45° FOV; 2212 by 1659 pixels: 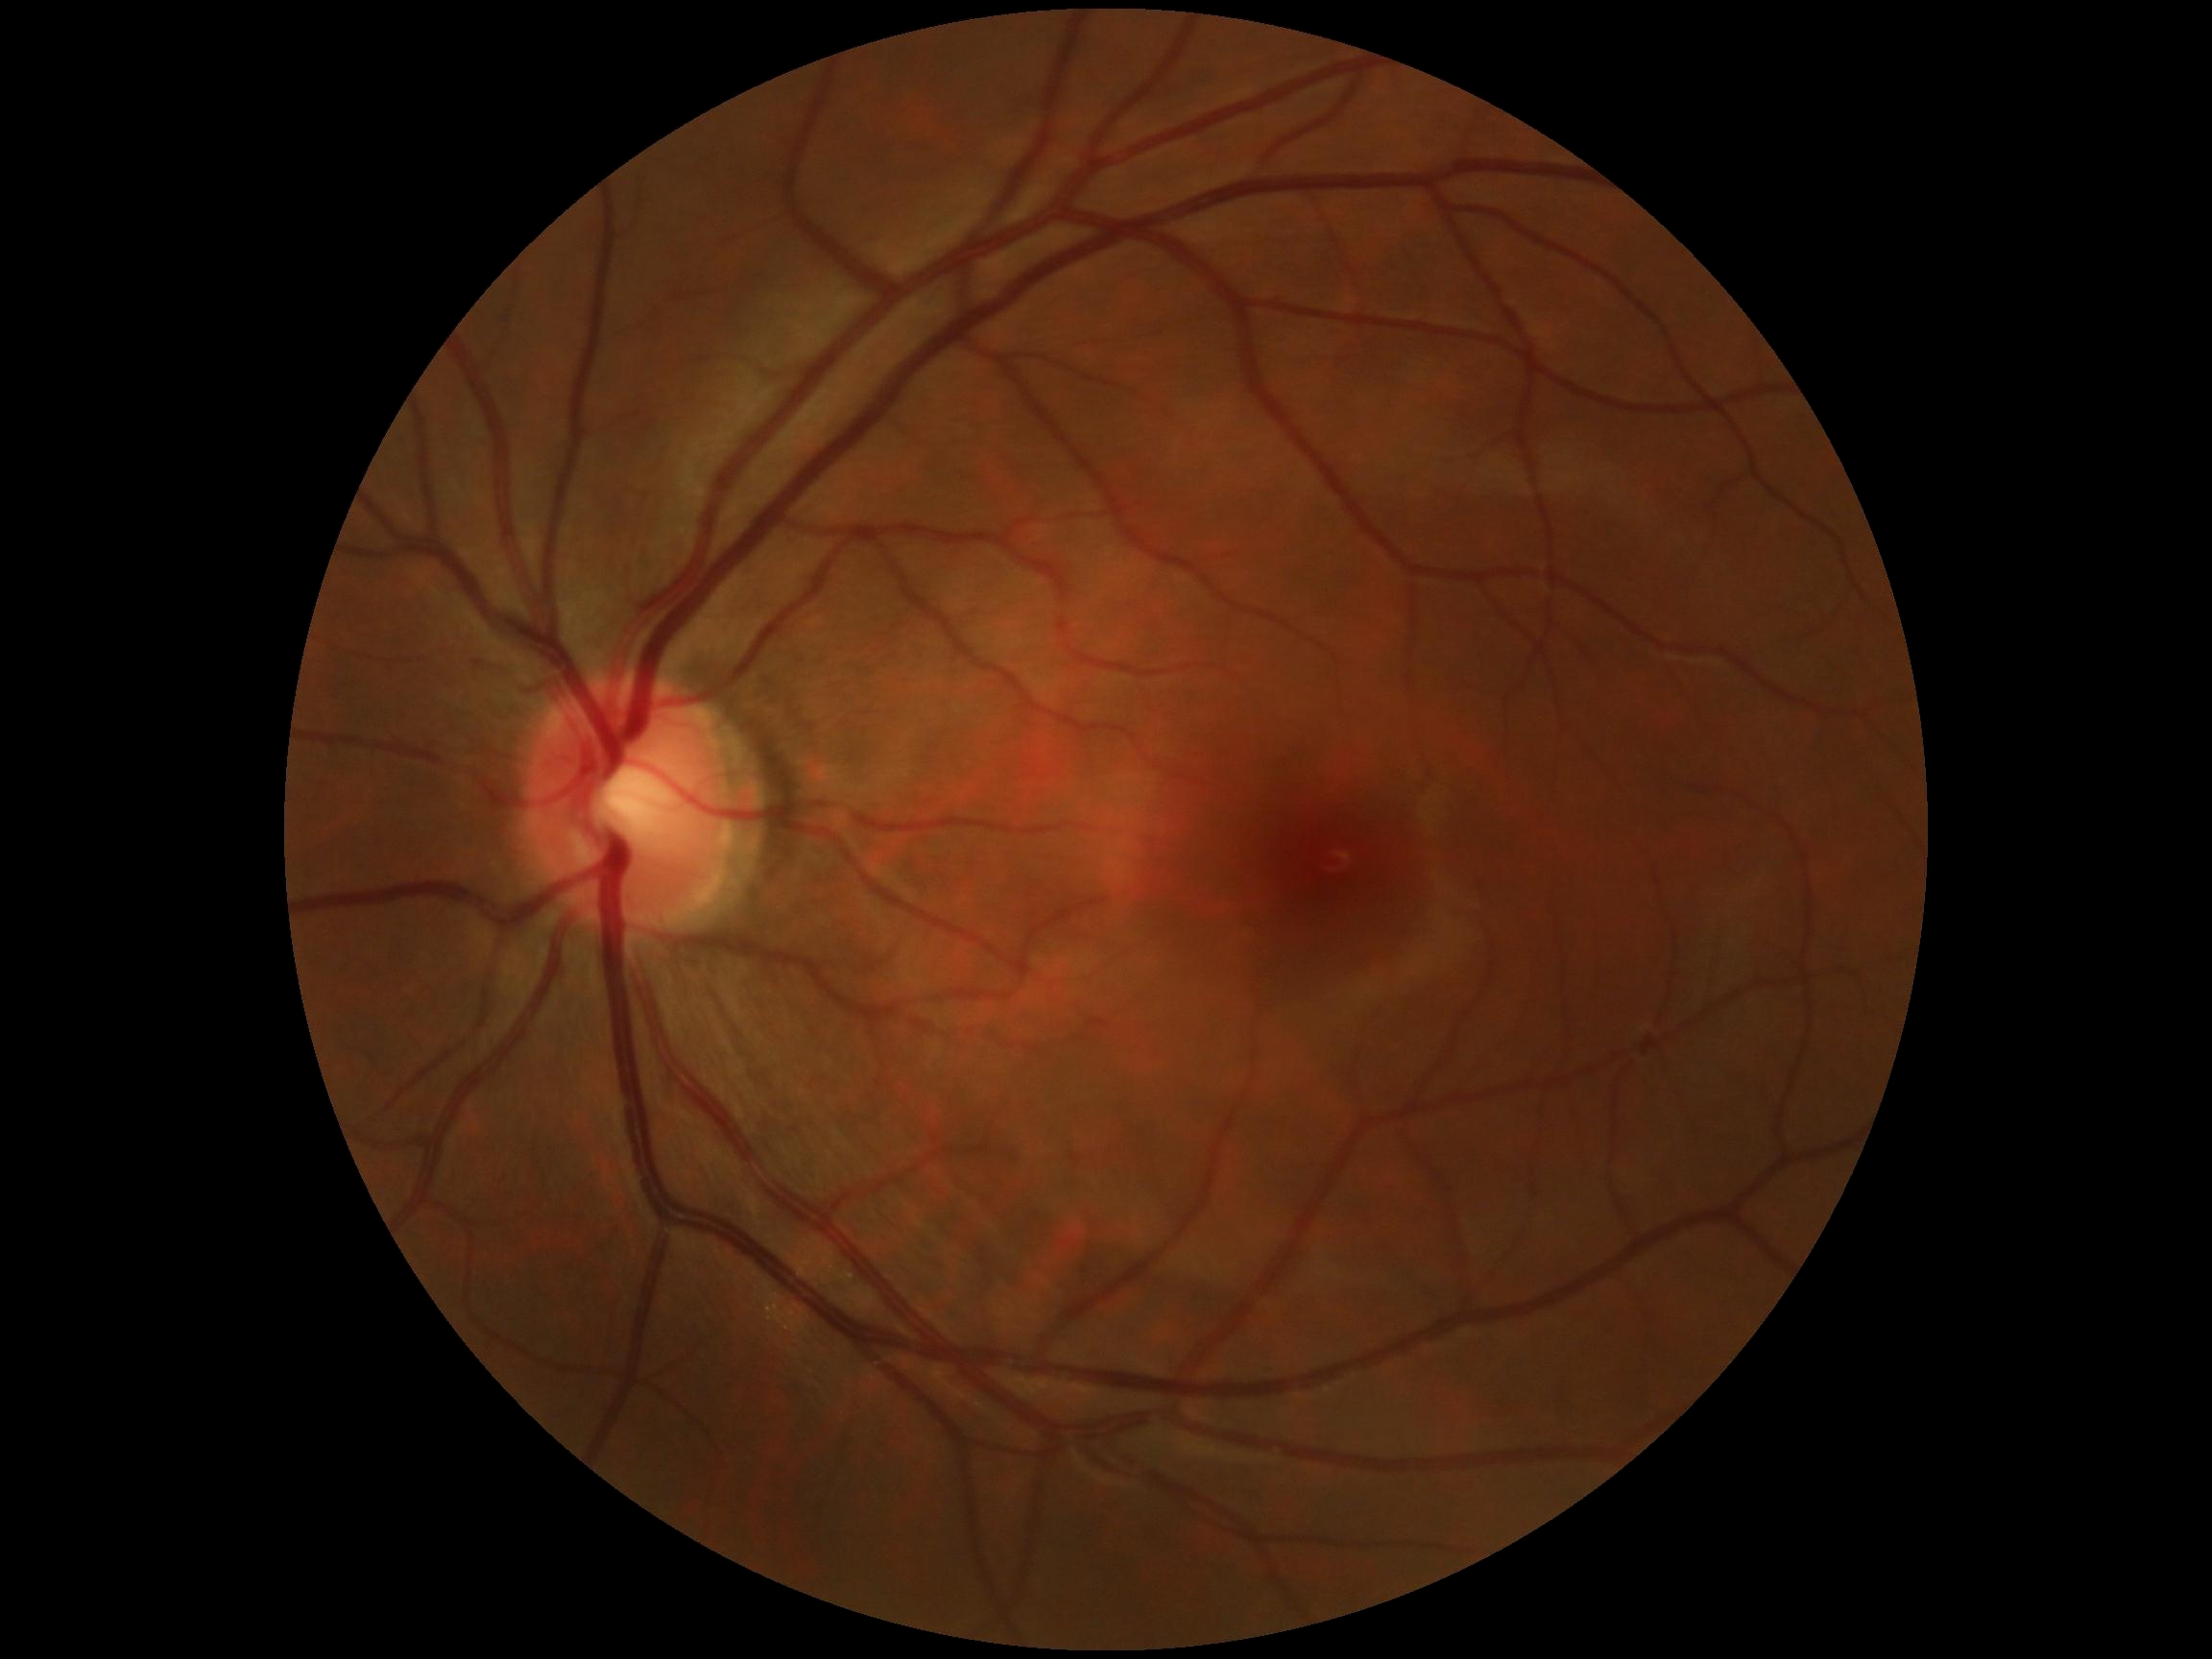
Findings:
– diabetic retinopathy (DR) — grade 0